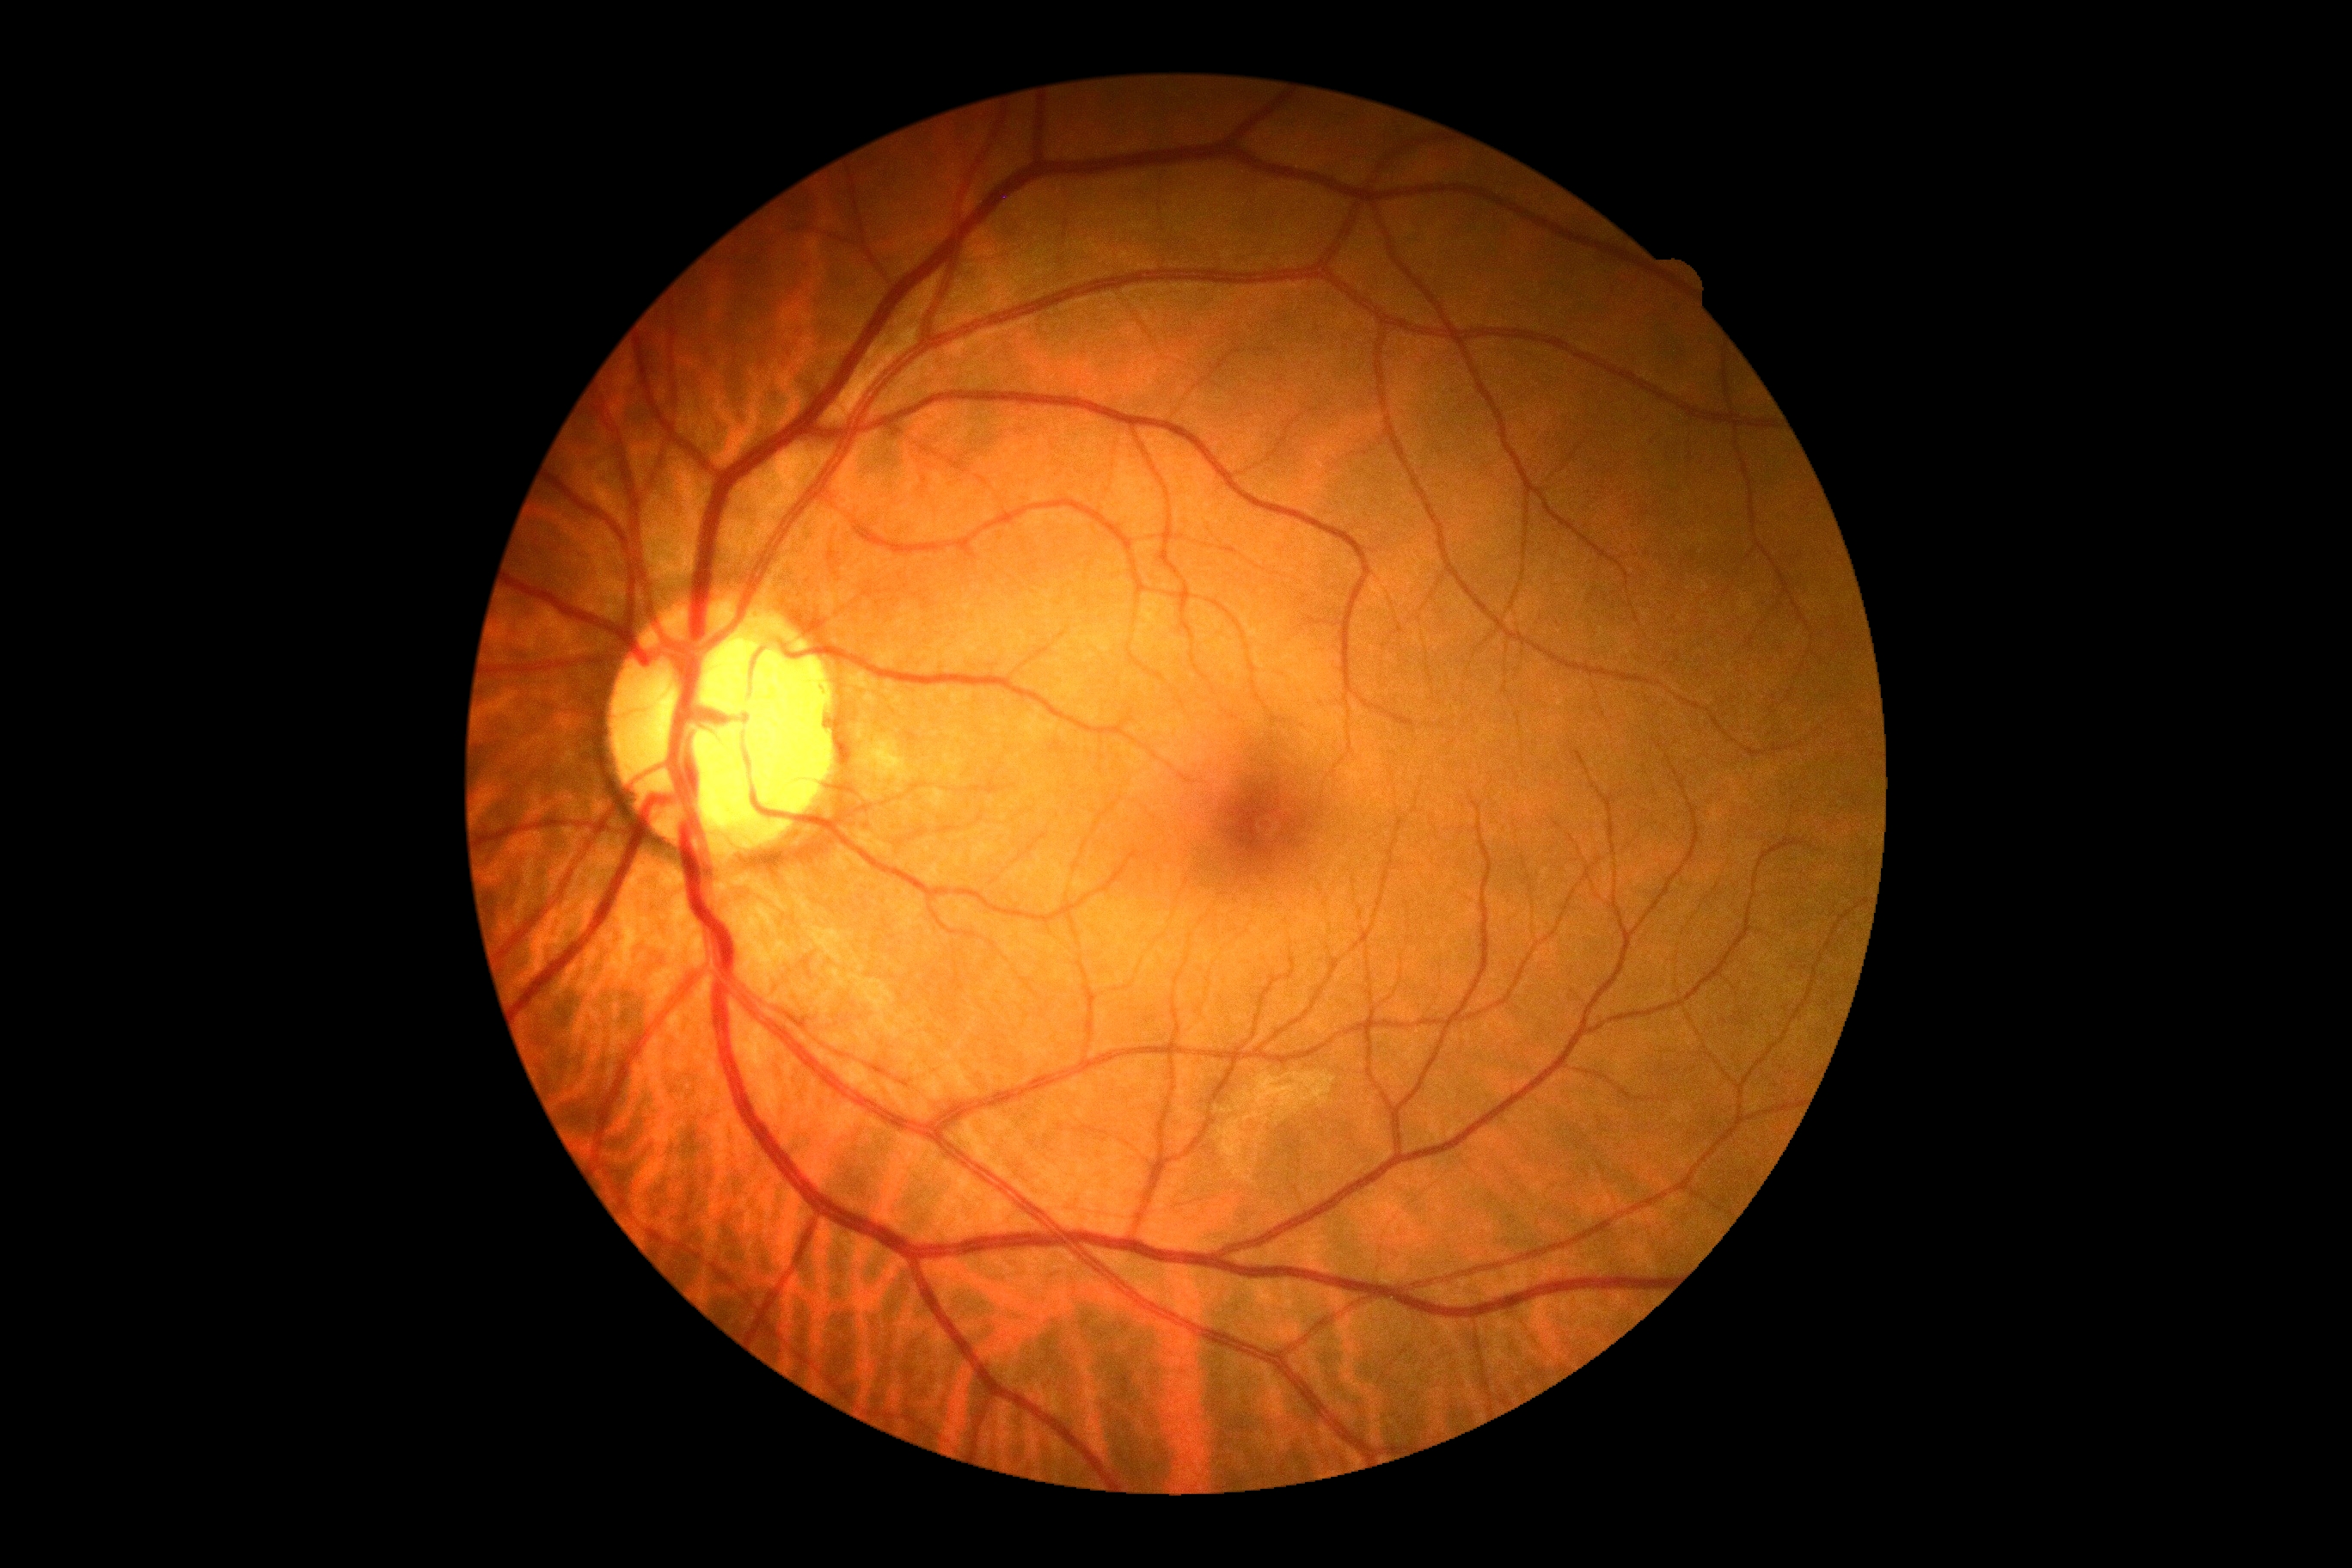

Retinopathy is grade 0. No DR findings.